NIDEK AFC-230.
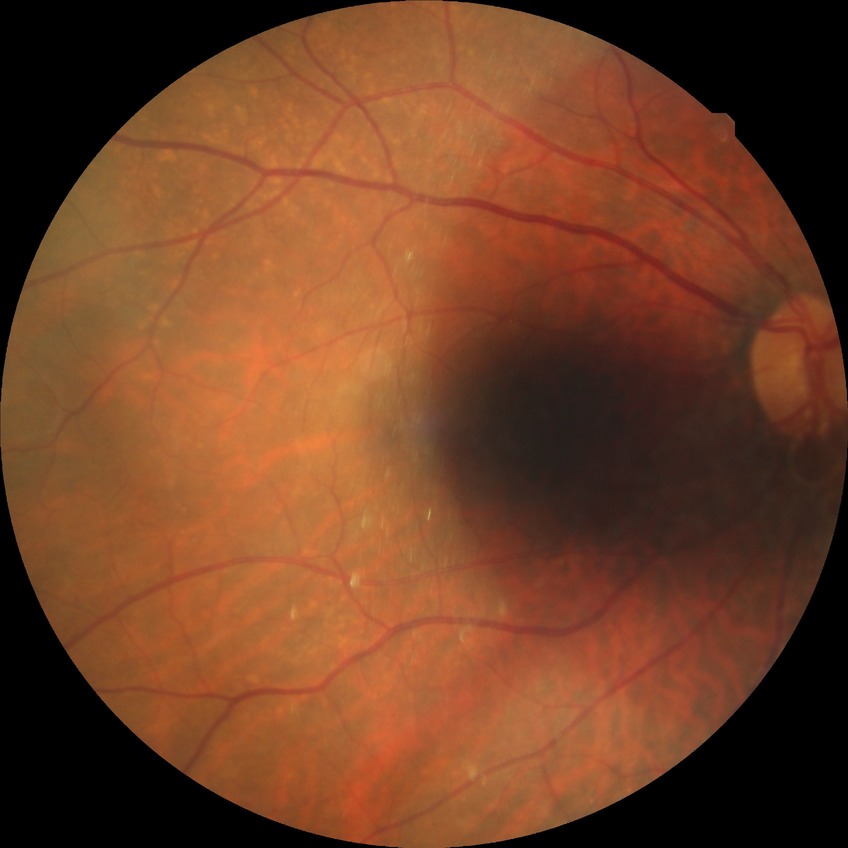 Modified Davis grade is NDR.